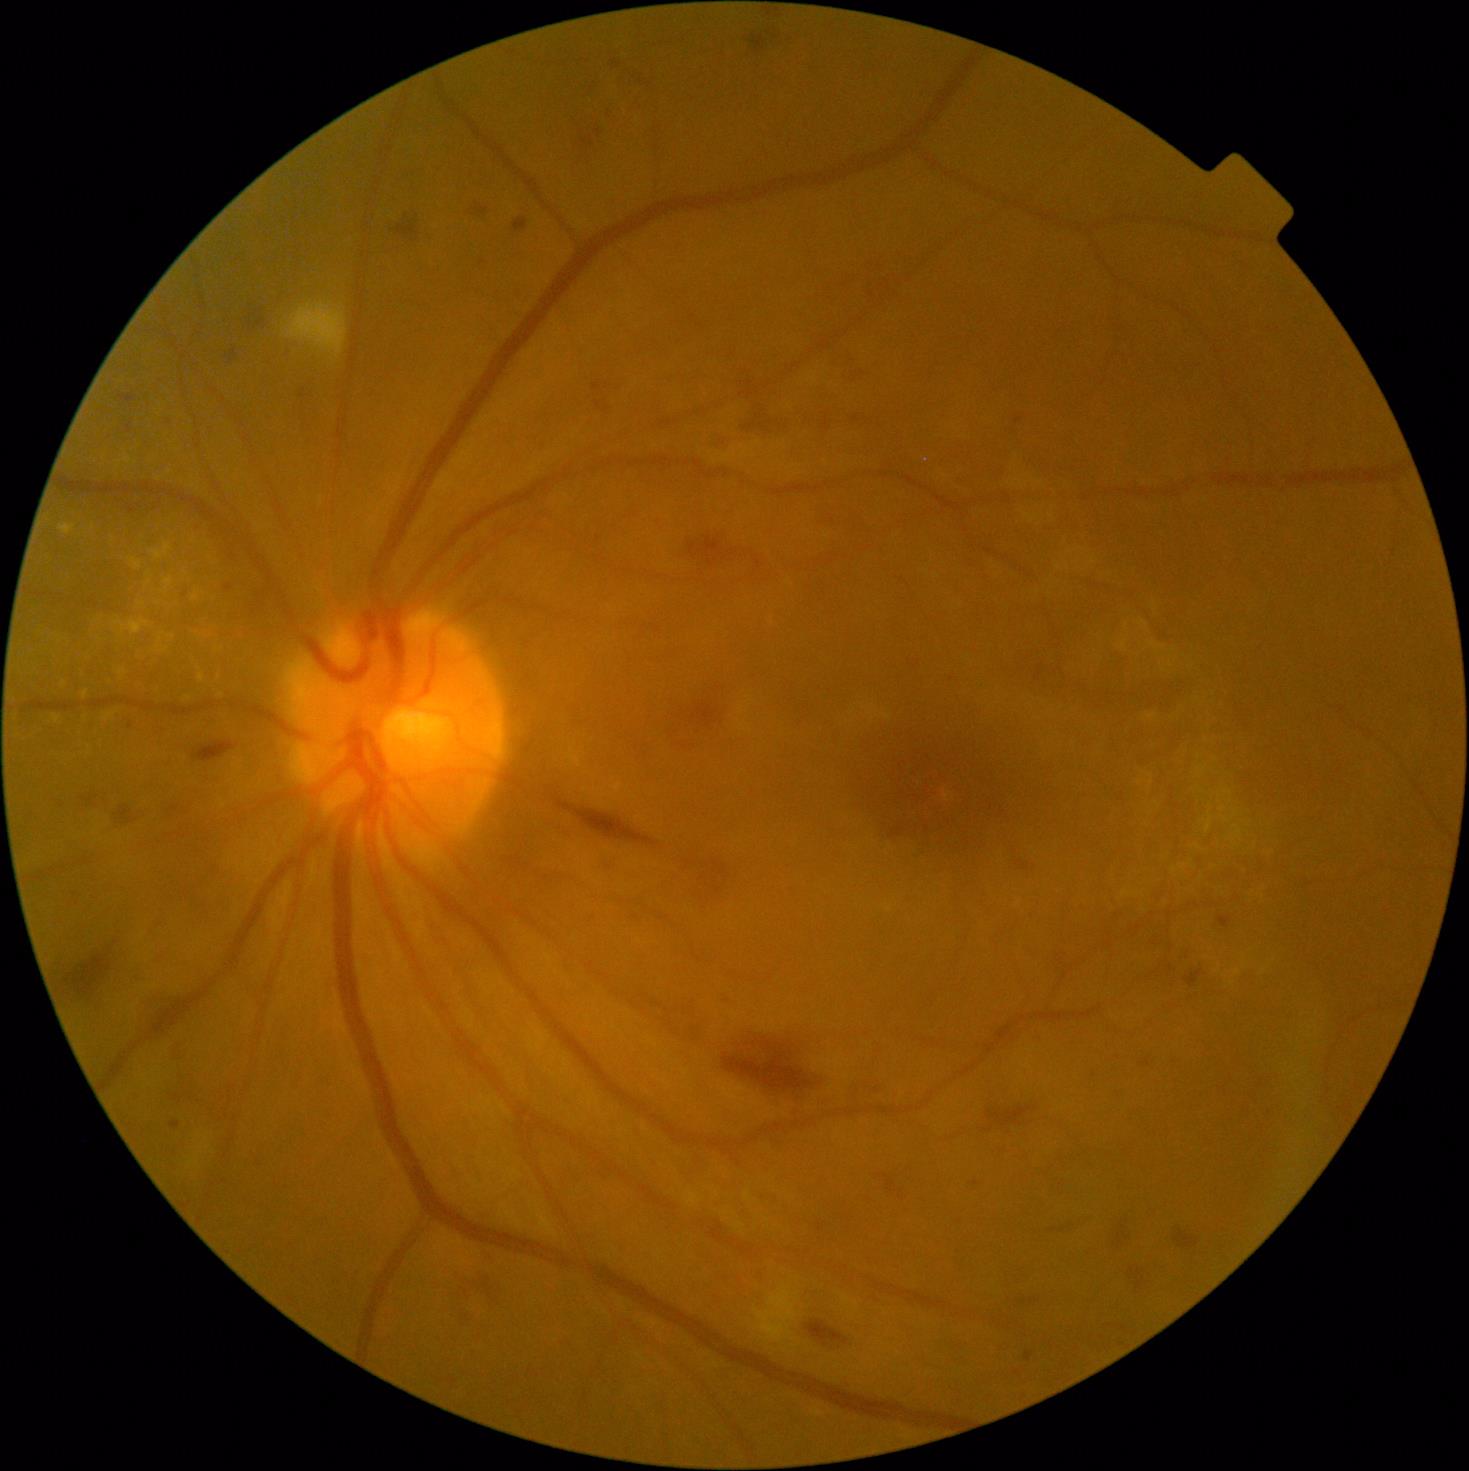
retinopathy: grade 2, DR class: non-proliferative diabetic retinopathy.